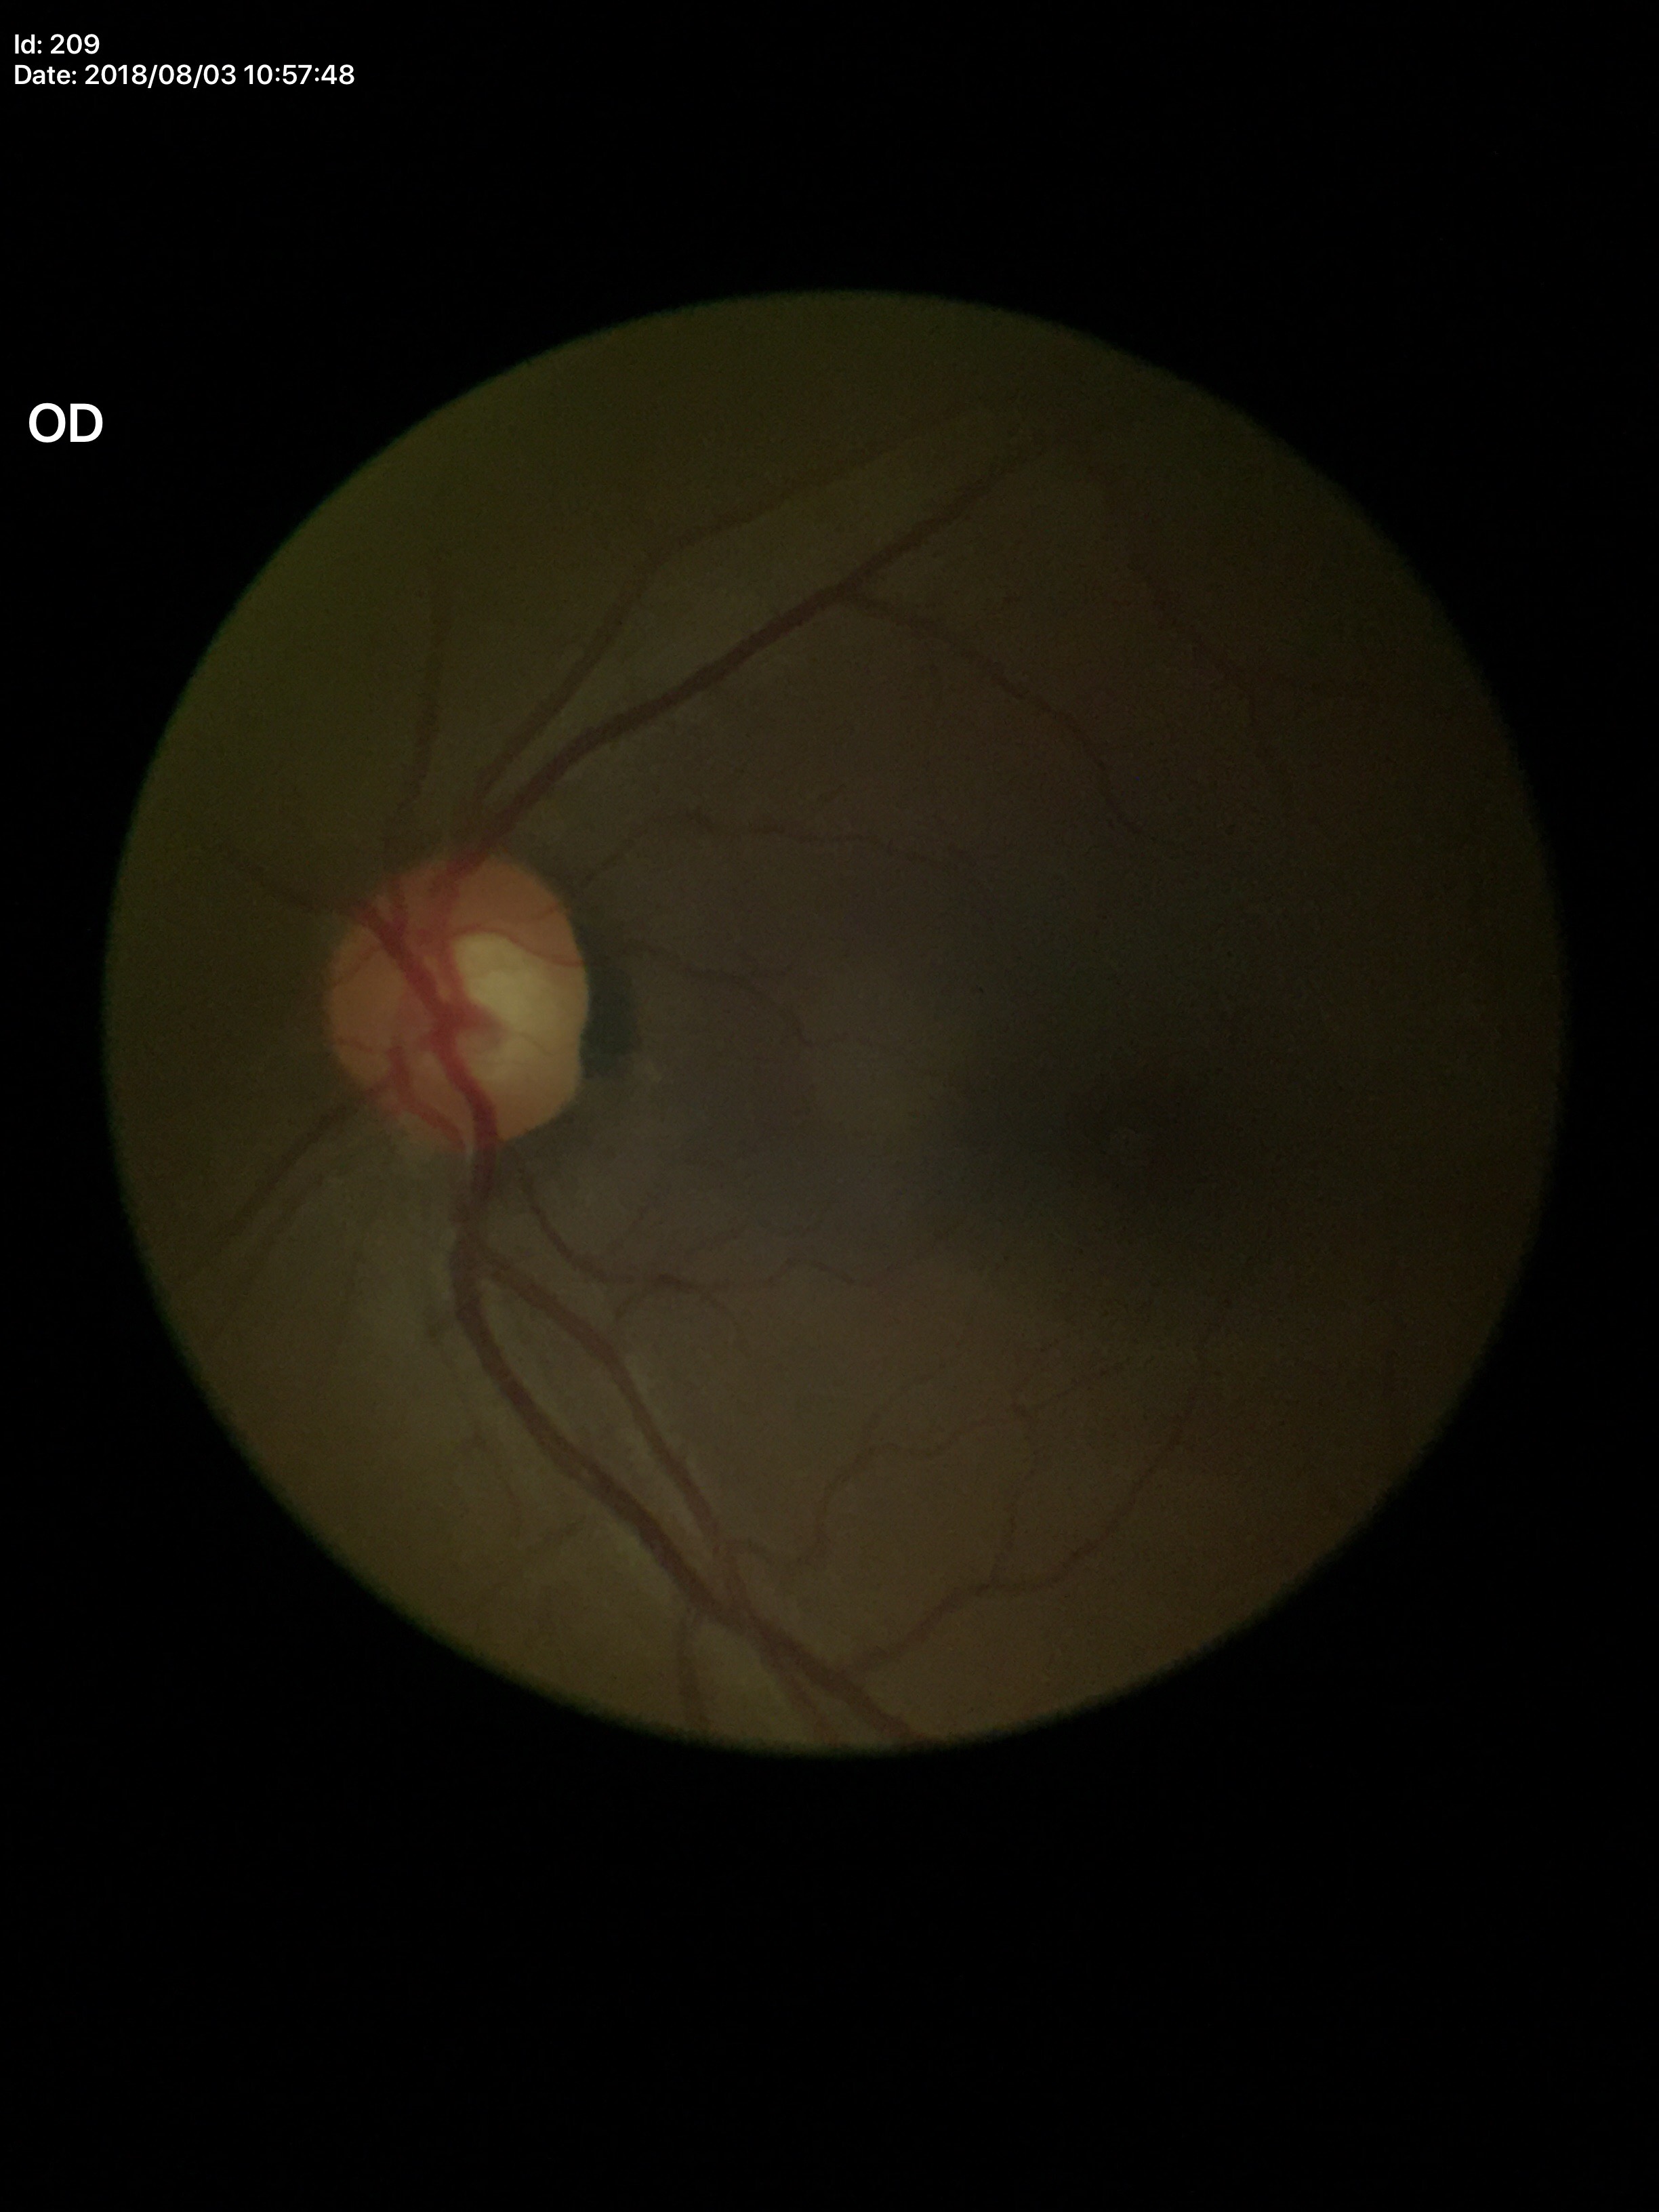 - Glaucoma assessment — negative
- vertical cup-disc ratio — 0.52
- horizontal cup-disc ratio — 0.55
- area CDR — 0.29